Image size 1240x1240; camera: Phoenix ICON (100° FOV); wide-field fundus image from infant ROP screening — 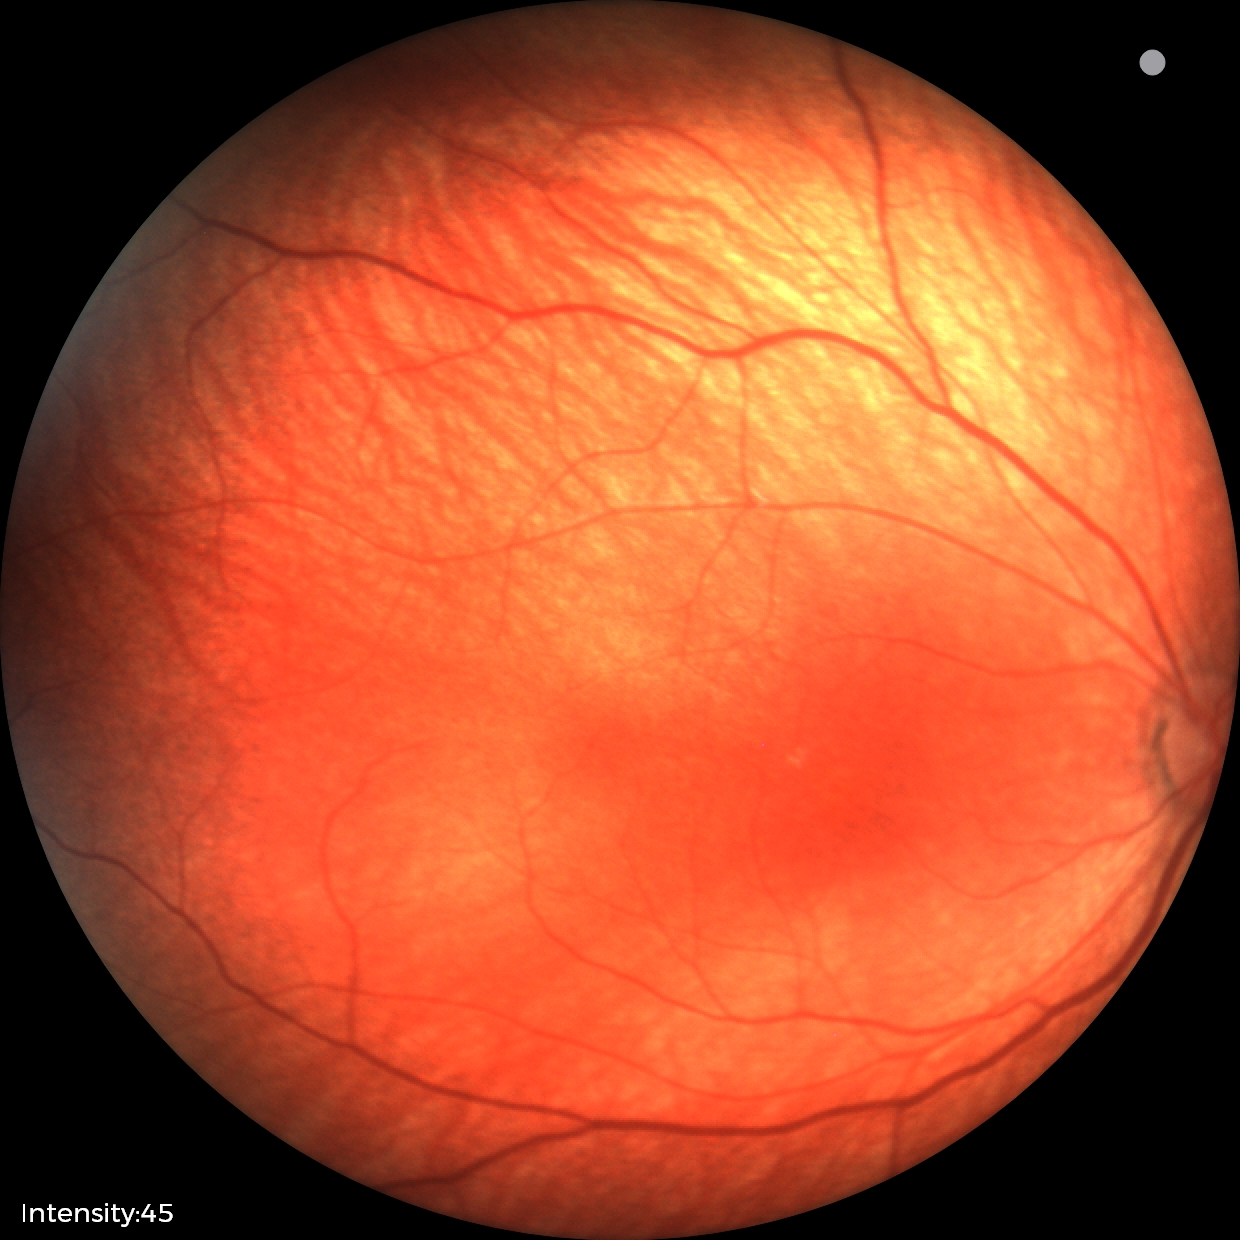 No retinal pathology identified on screening.